FOV: 50 degrees — 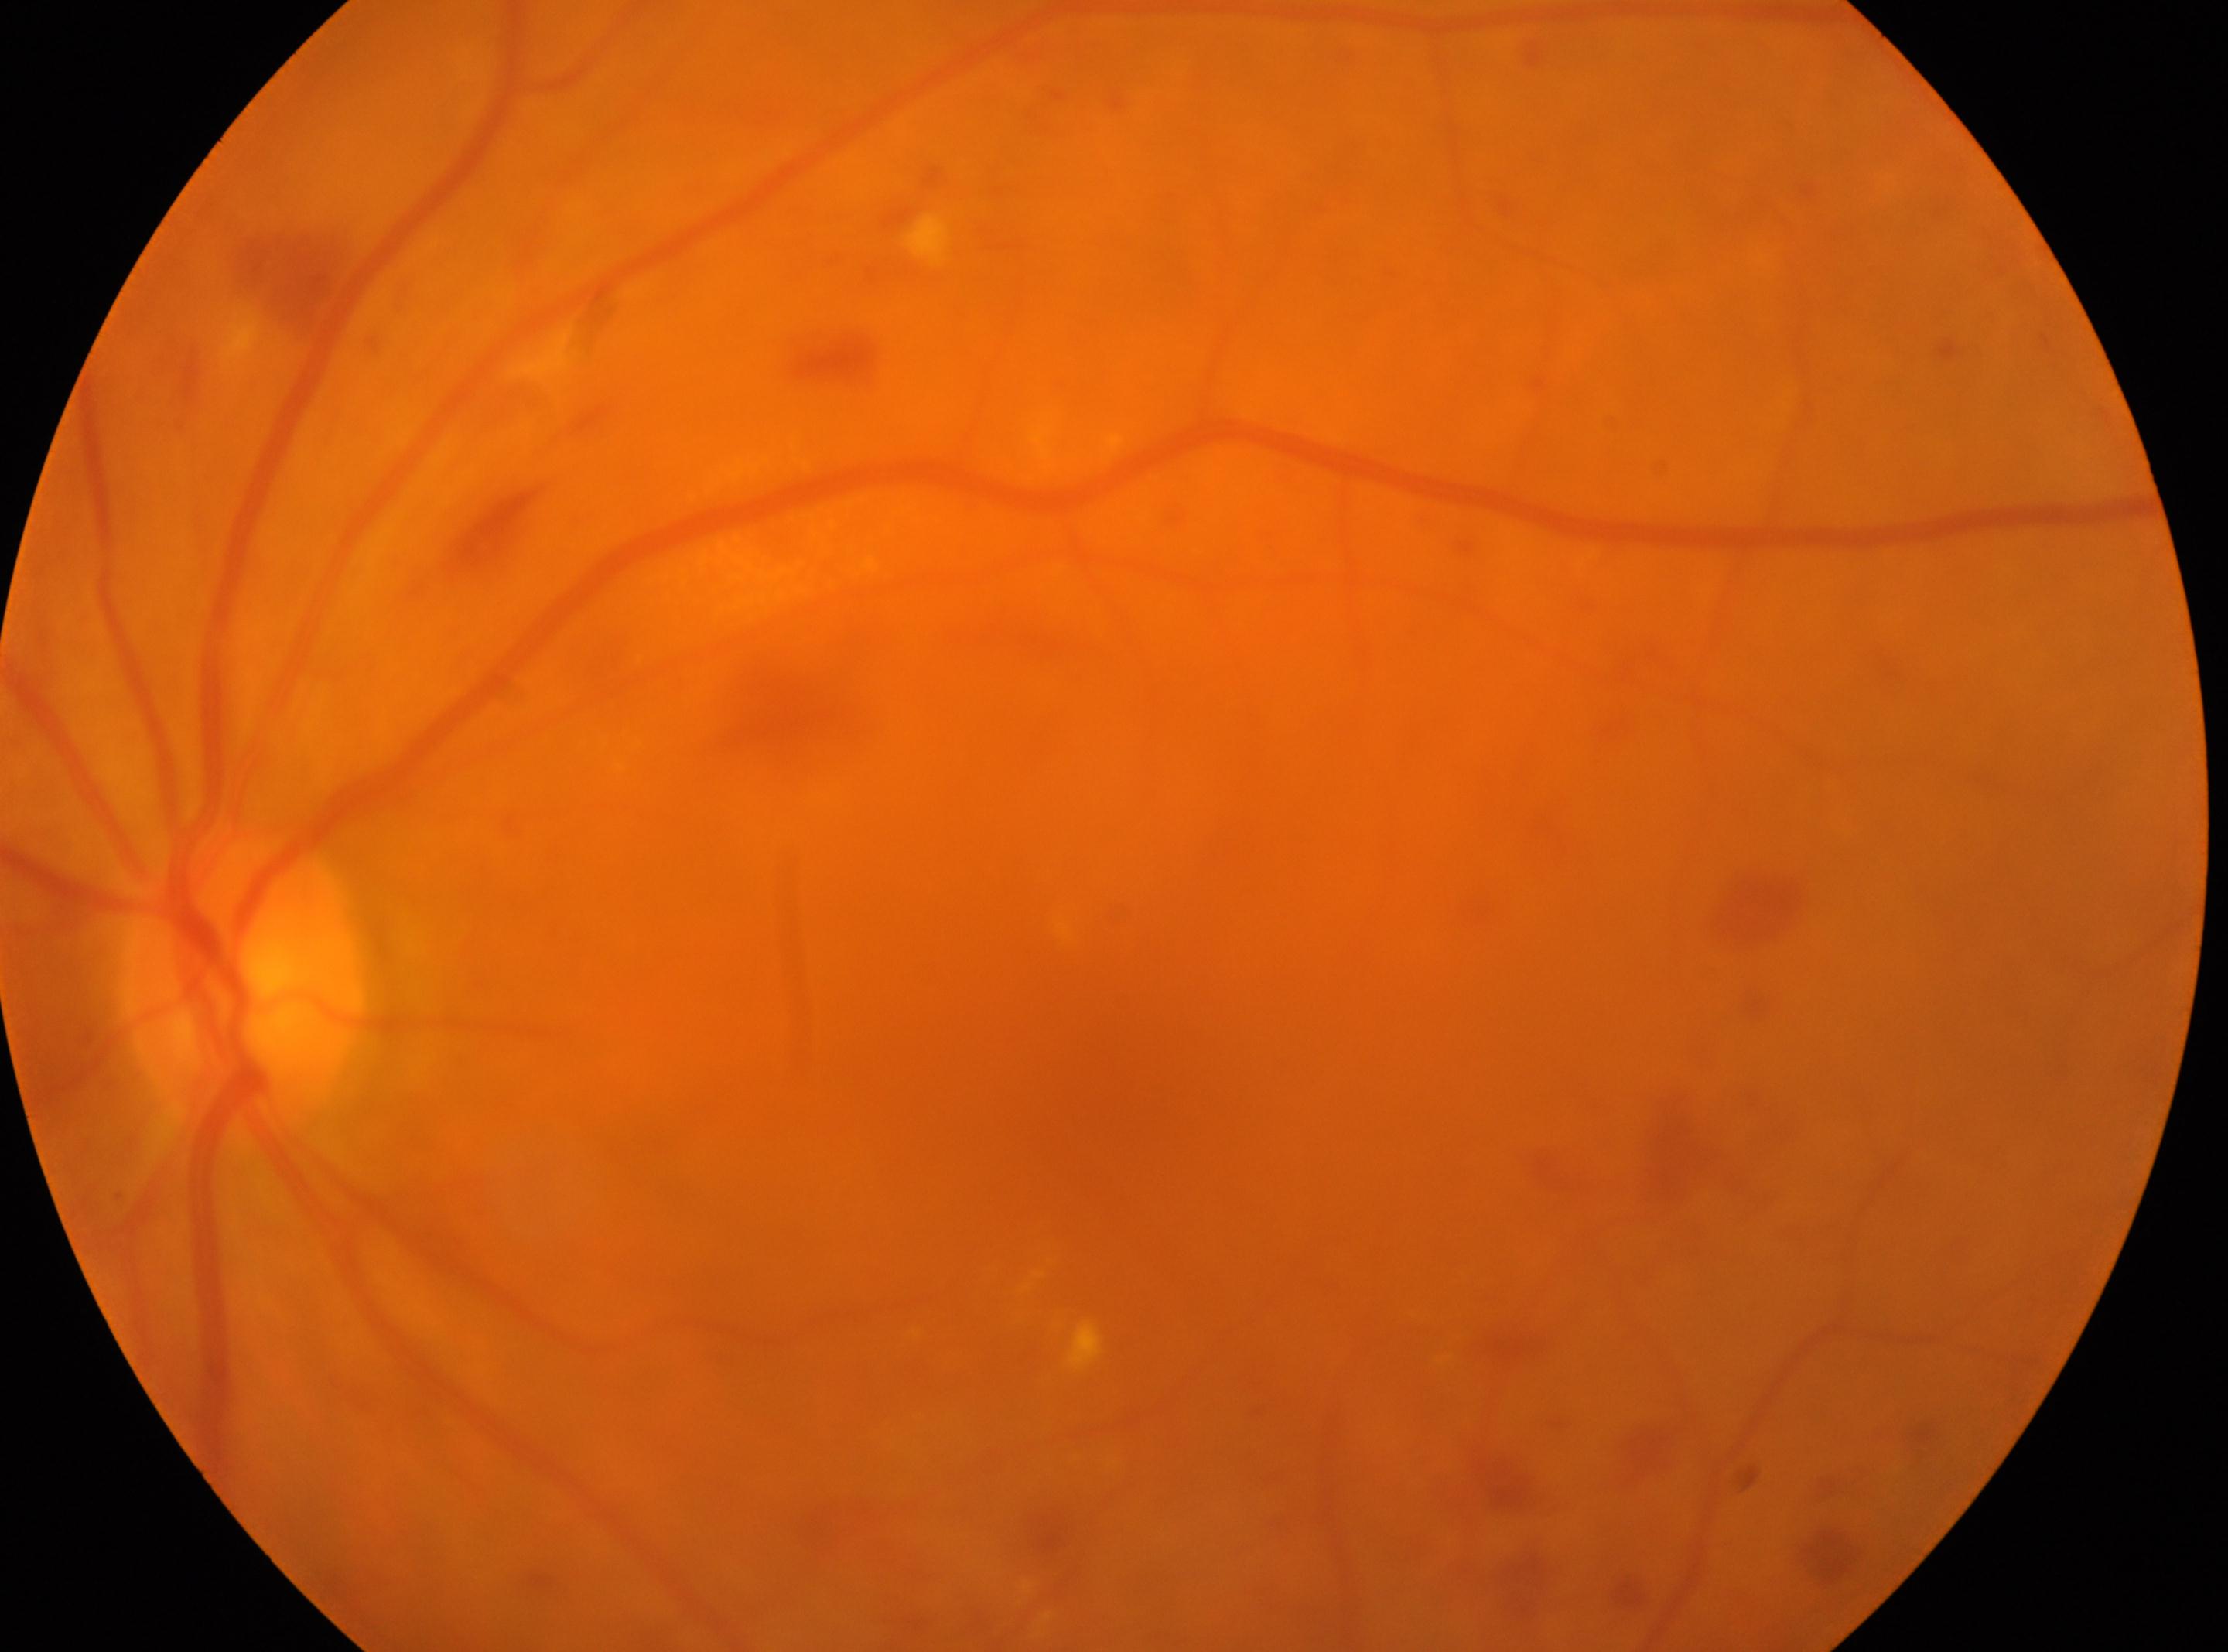

Foveal center located at (x=1125, y=1121). The disc center is at (x=241, y=988). The image shows the OS. DR grade is moderate NPDR (2).